Camera: Forus 3Nethra Classic fundus camera
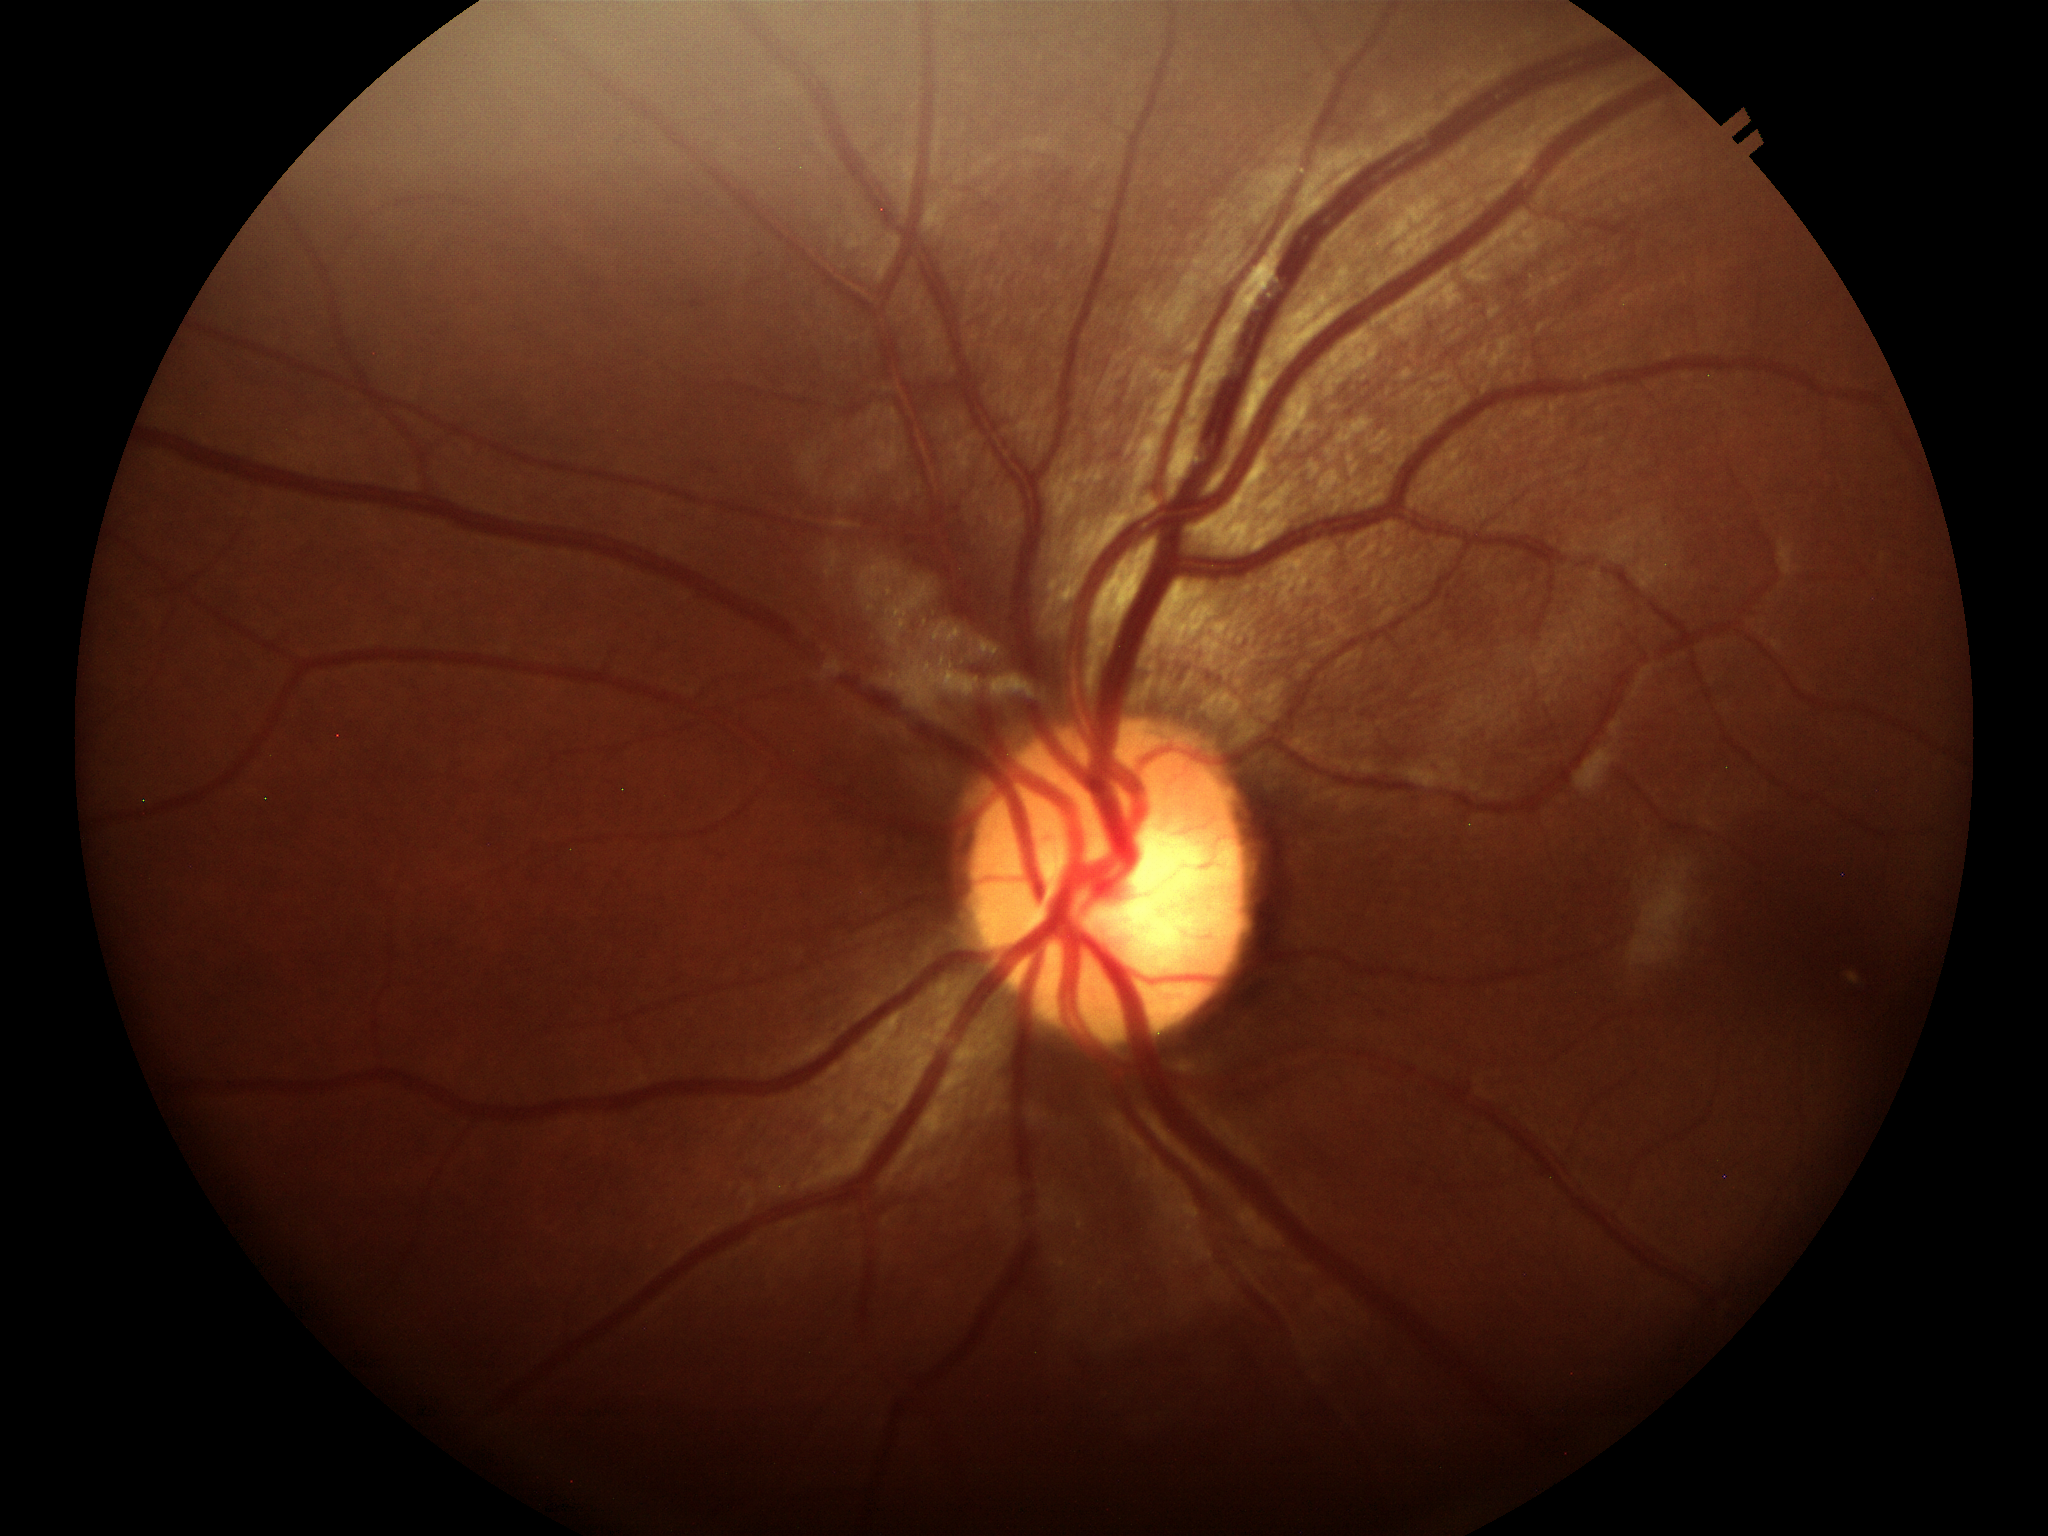

{"glaucoma_decision": "negative", "vcdr": "0.52"}